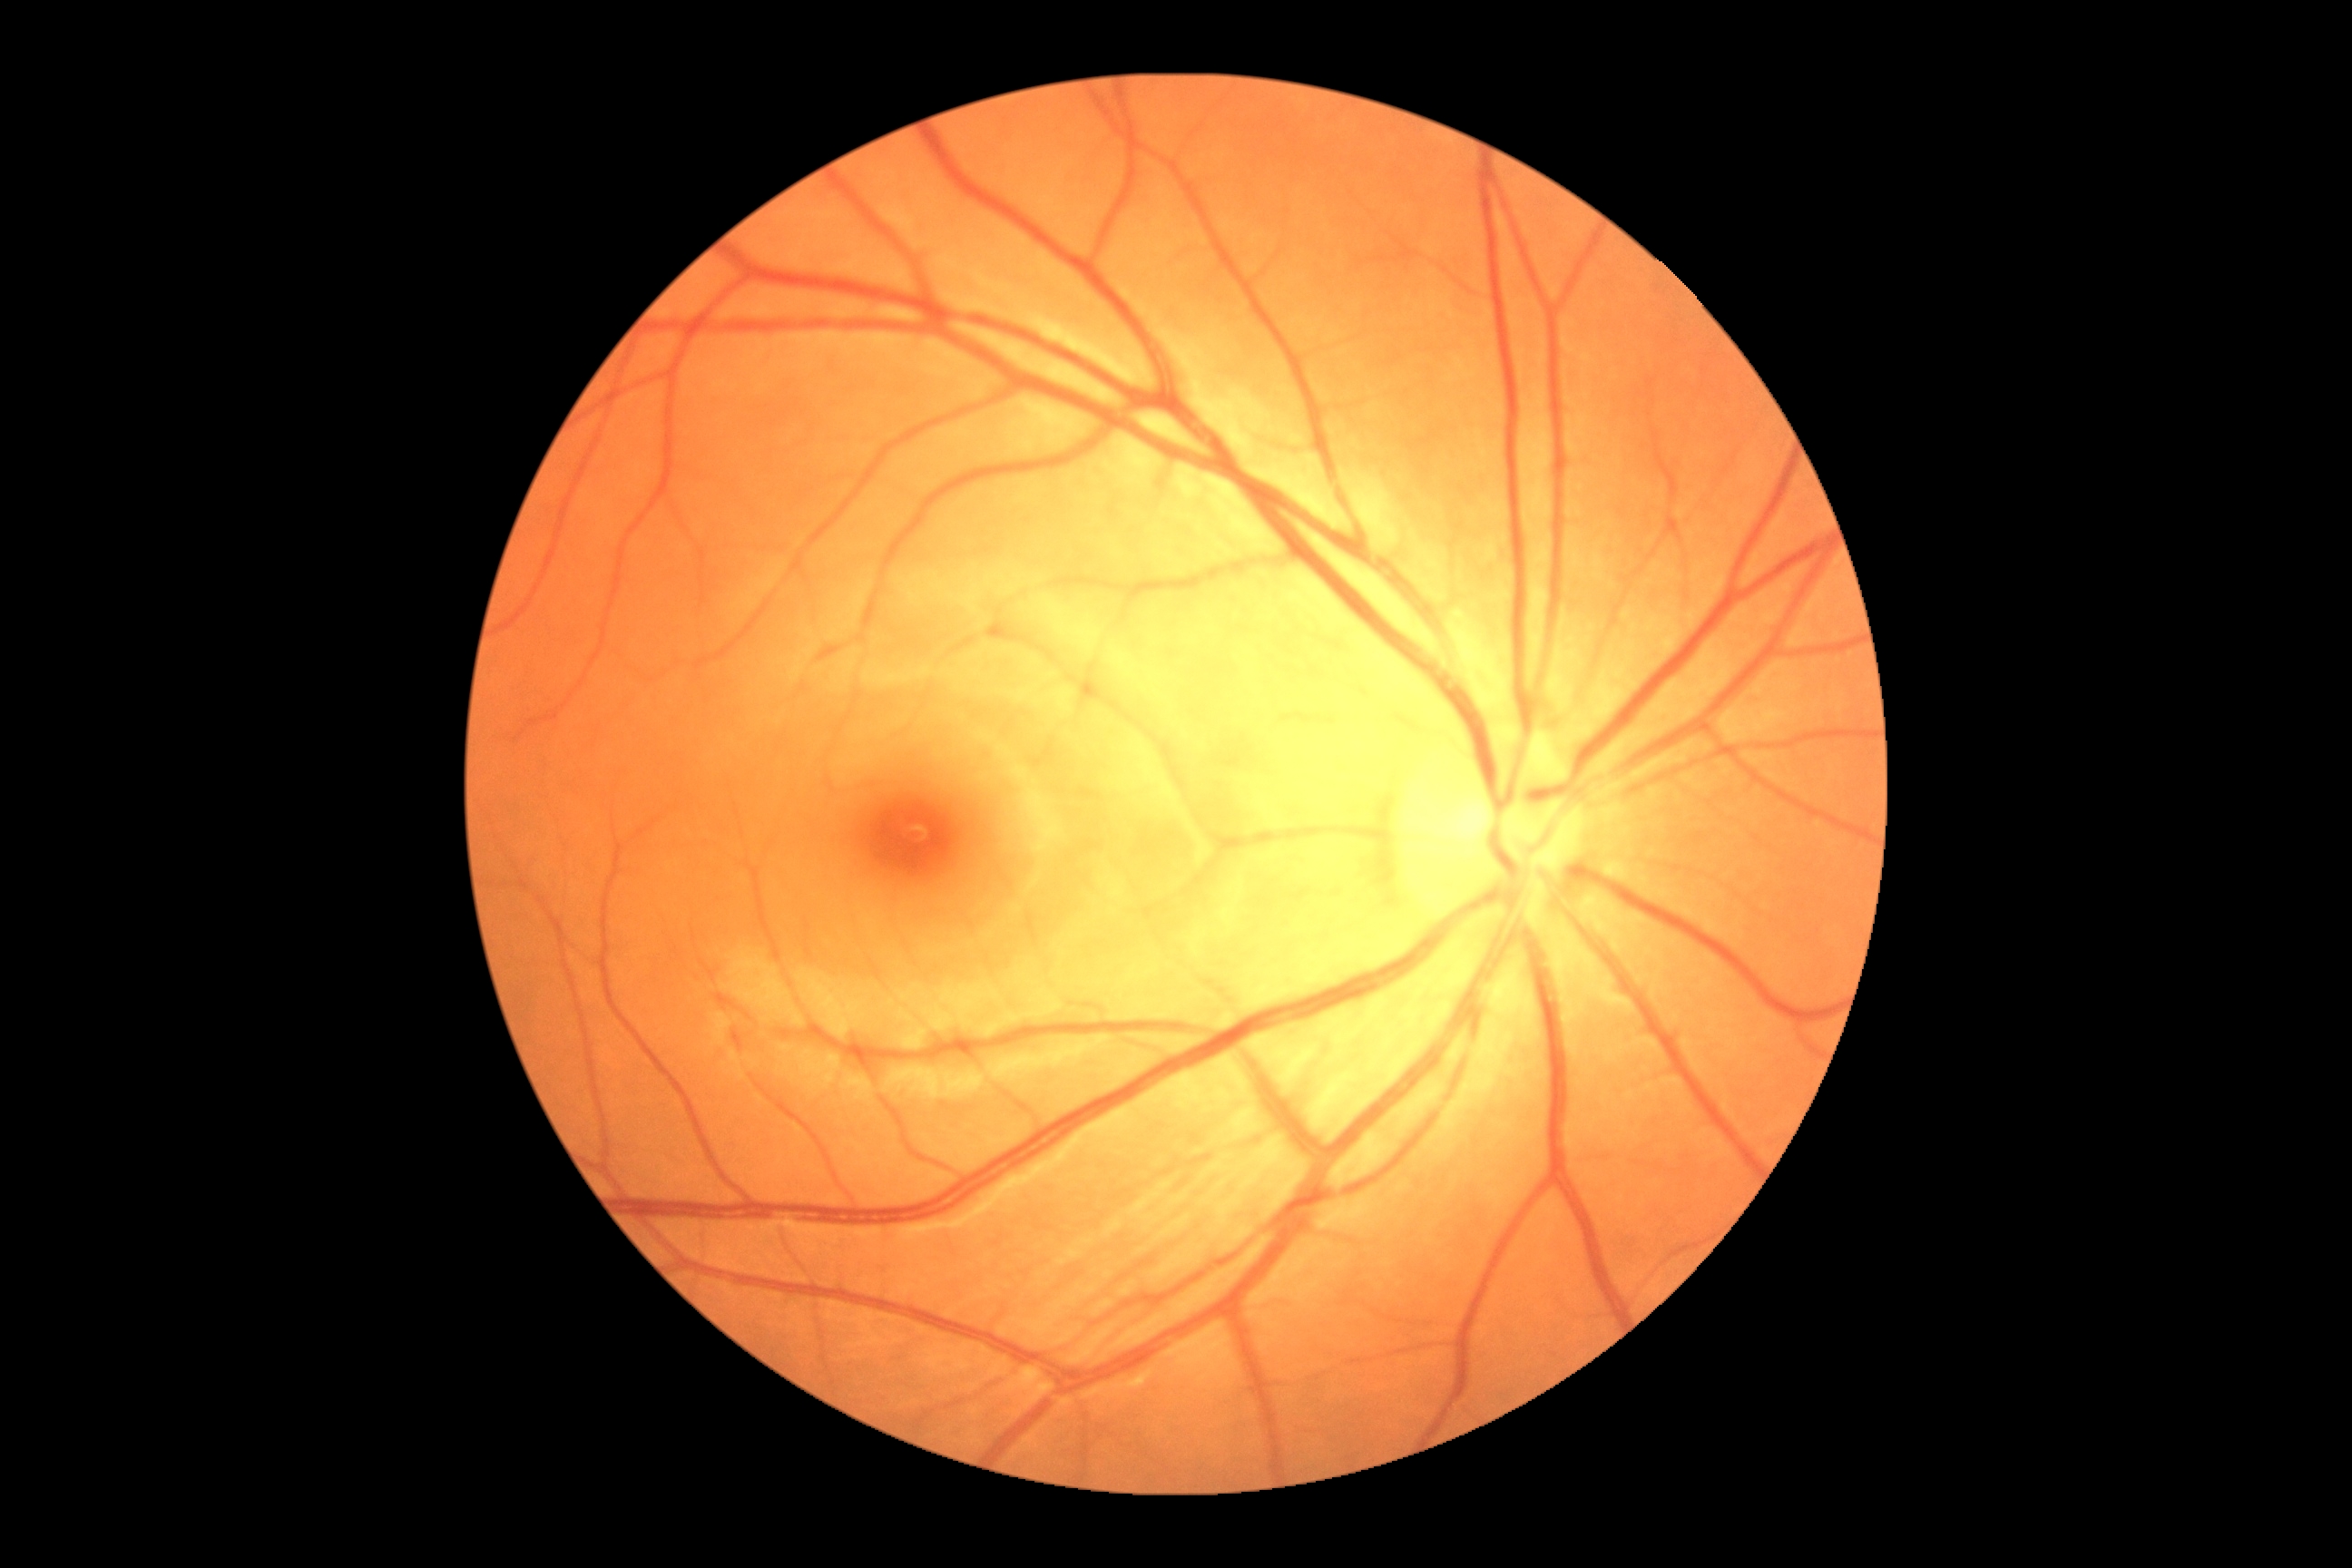
– DR grade — 0/4